Pediatric wide-field fundus photograph: 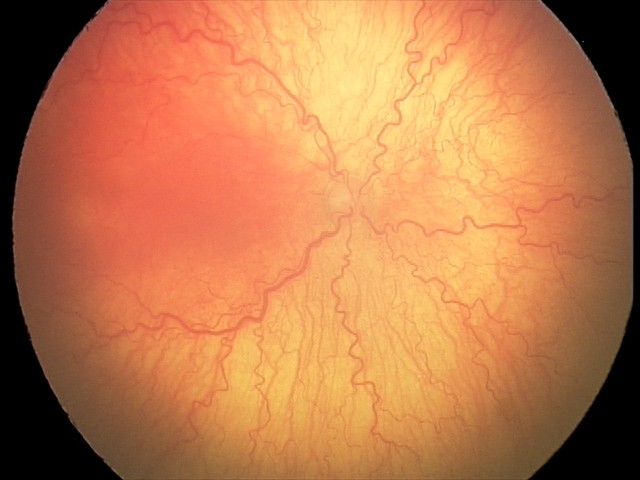

Impression: aggressive retinopathy of prematurity; plus disease.